2352x1568px, FOV: 45 degrees: 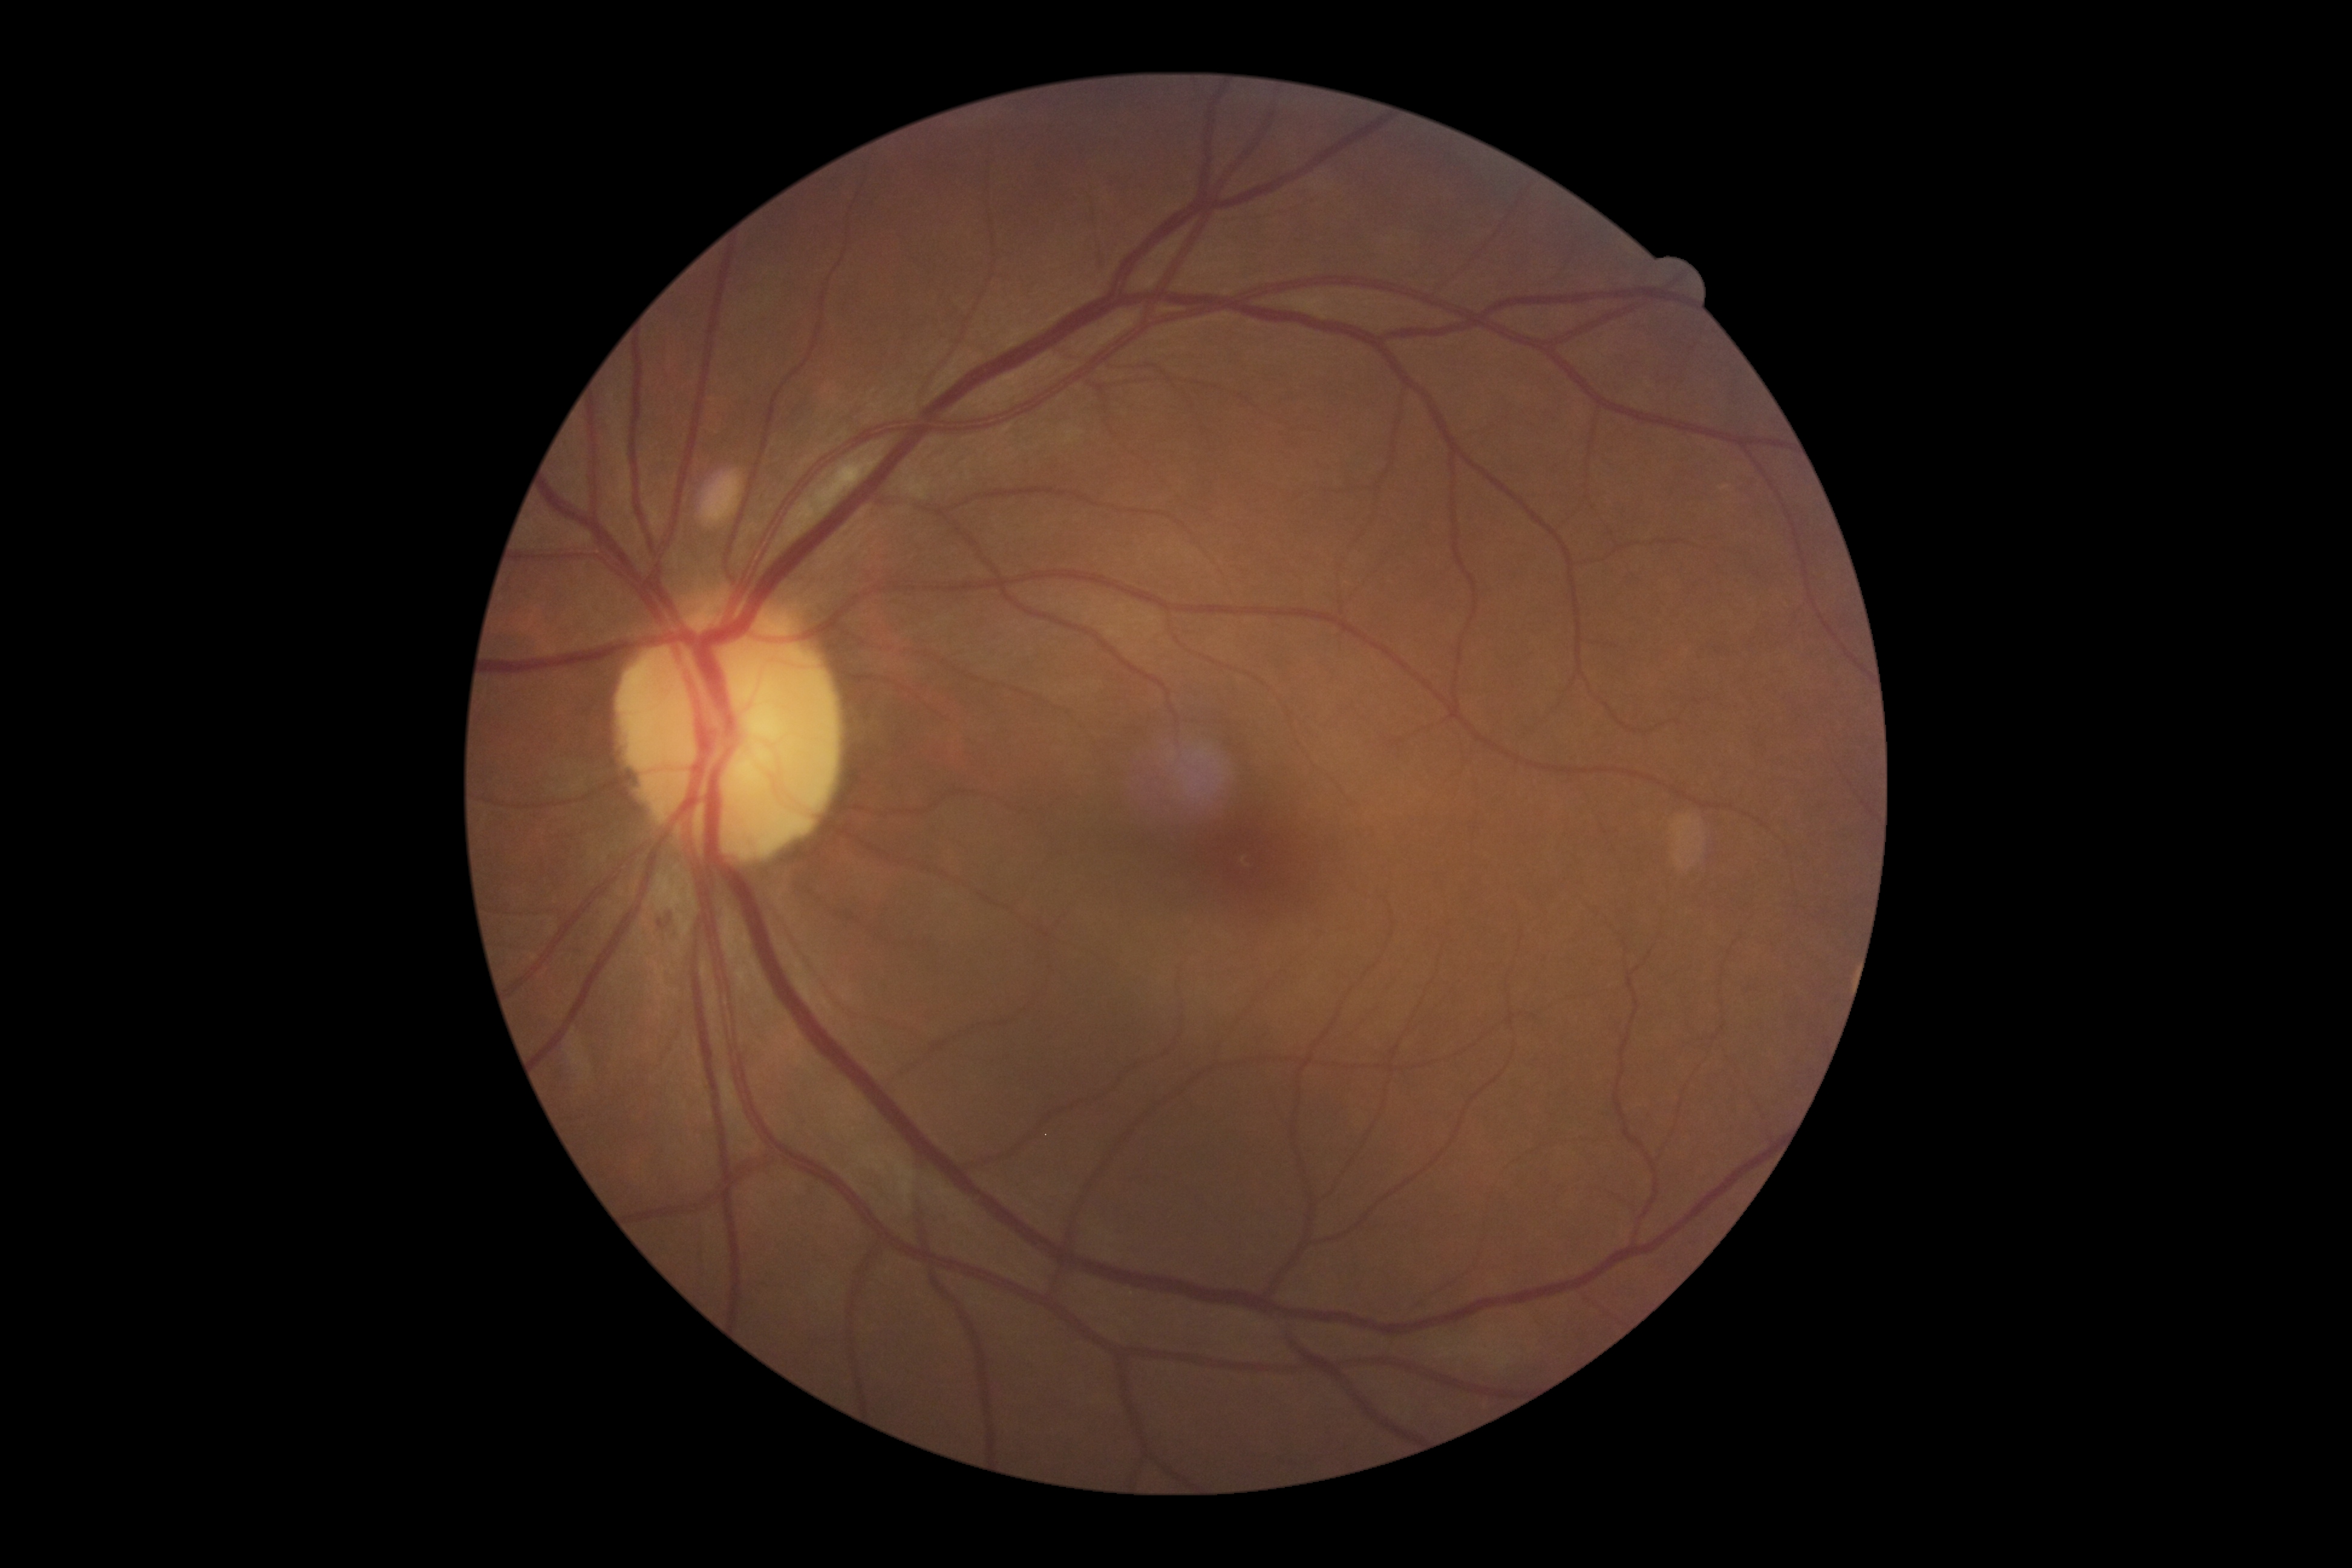

diabetic retinopathy grade: moderate NPDR (2).